Man patient; optic disc at the center of the field; pachymetry: 588 µm; 30° FOV; age 43; captured on a Topcon TRC-NW400 fundus camera; intraocular pressure 20 mmHg; captured without pupil dilation.
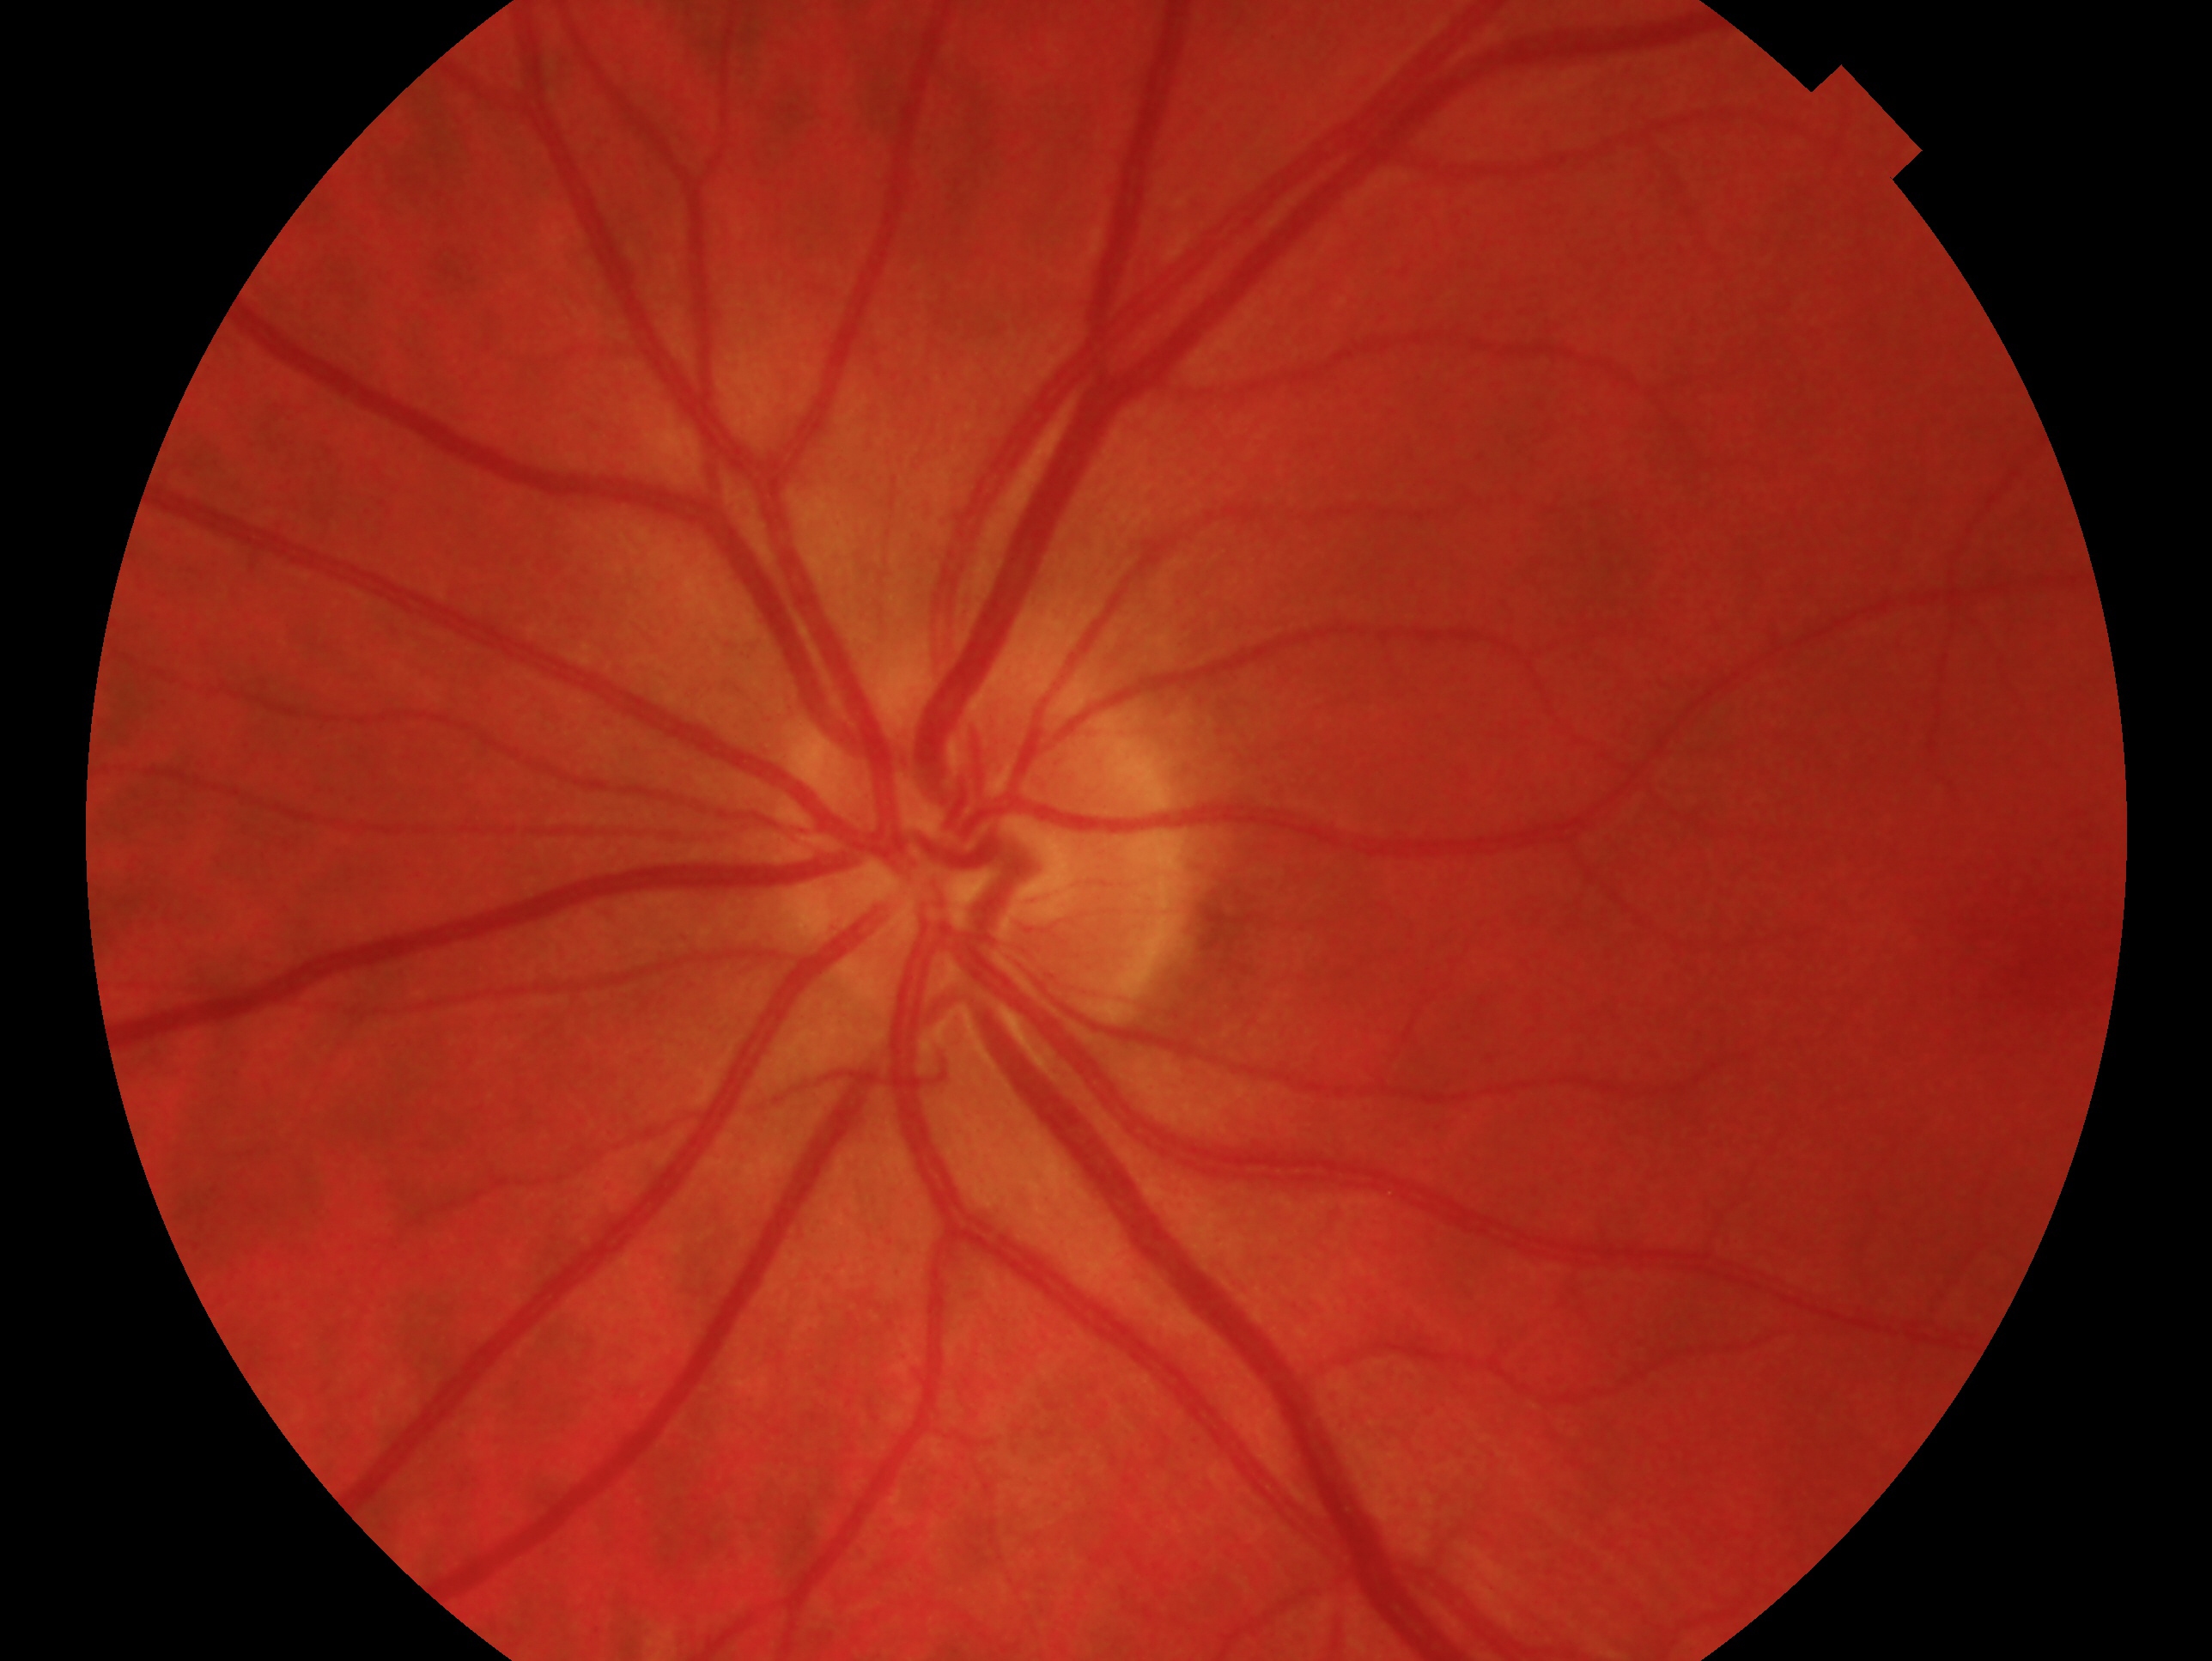

Impression — no glaucomatous findings. The image shows the oculus sinister.